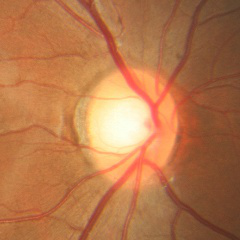
Fundus image with findings of no glaucoma.